Fundus photo: 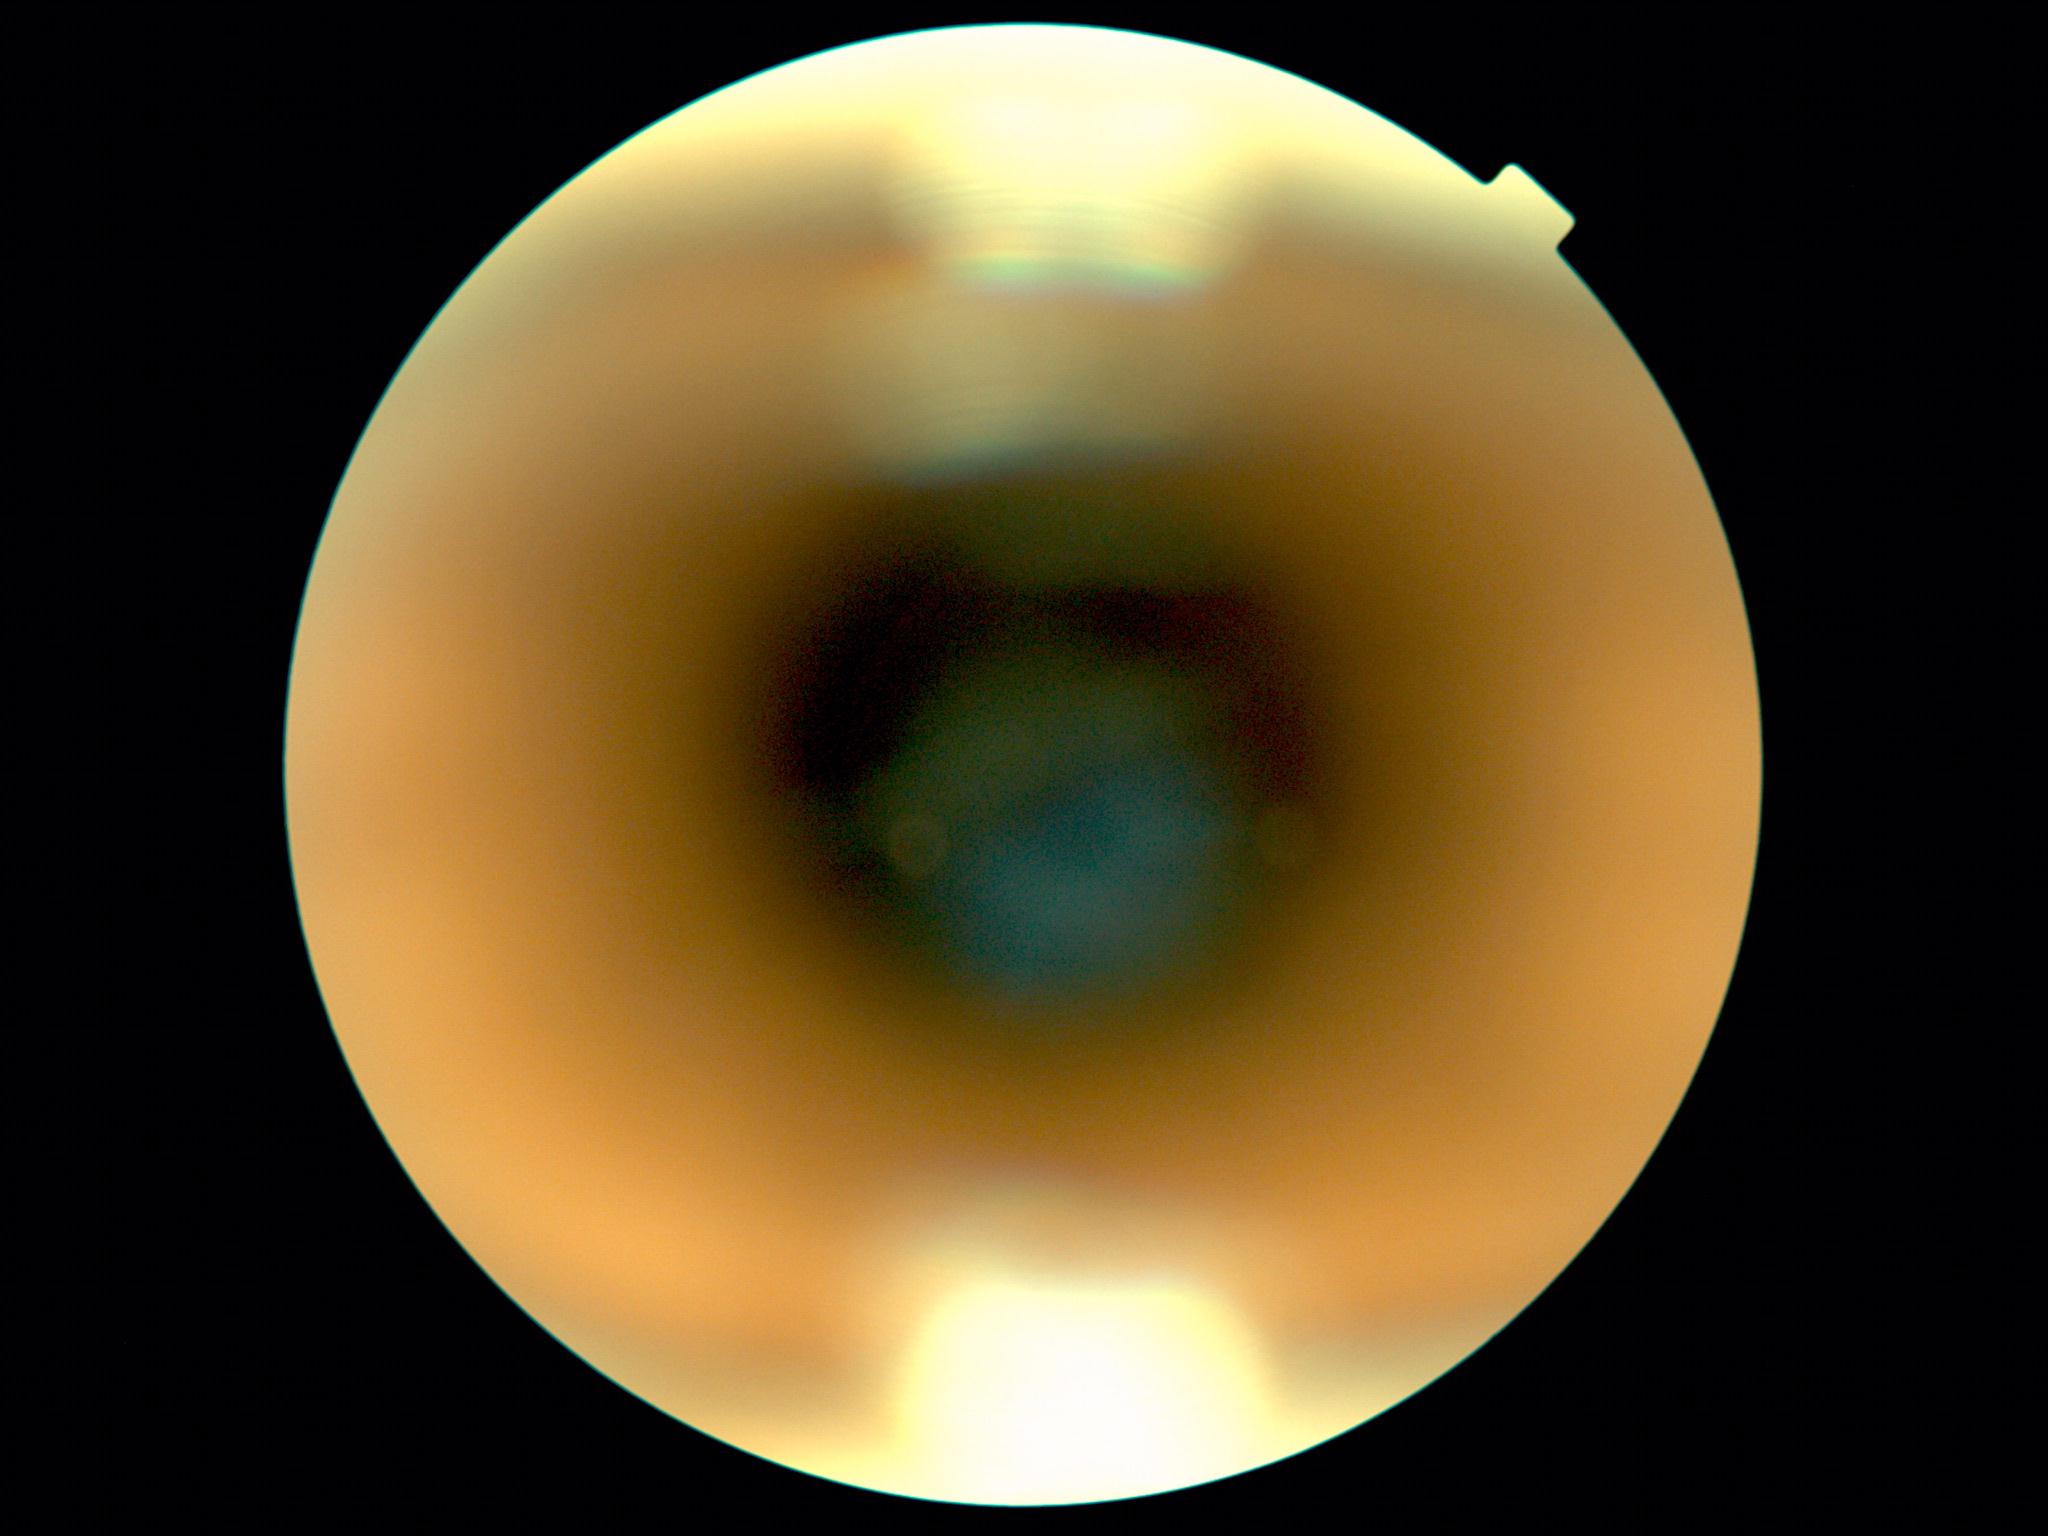

  quality: insufficient
  dr_grade: ungradable due to poor image quality